Color fundus image; 50° FOV — 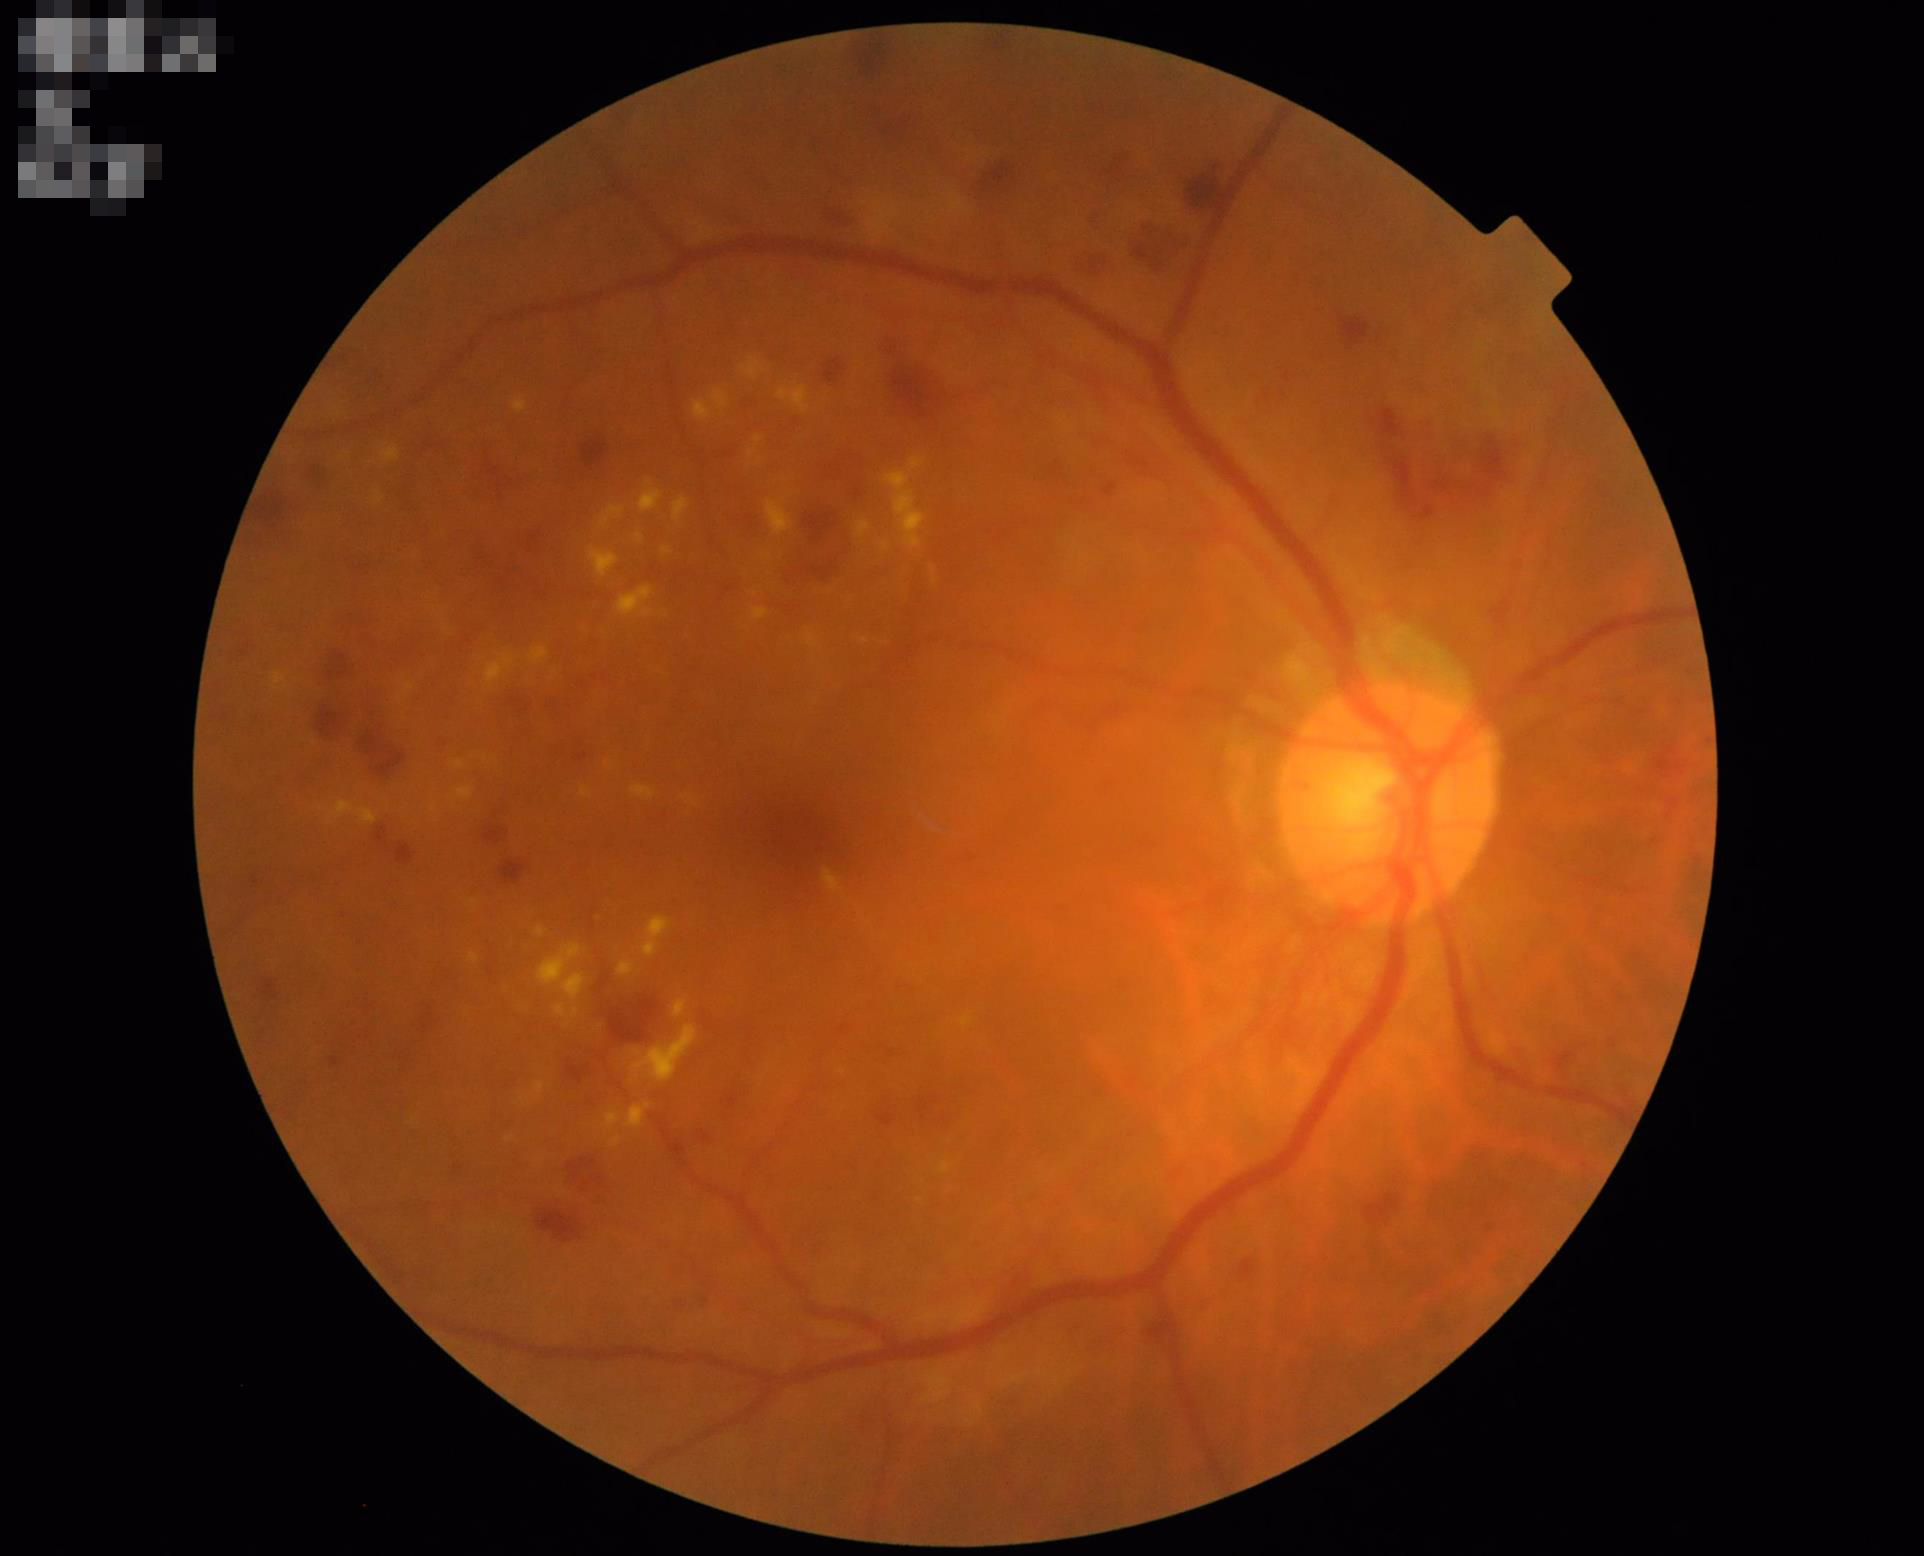 Illumination and color balance are good. Image is sharp throughout the field. Overall image quality is good. Good dynamic range.